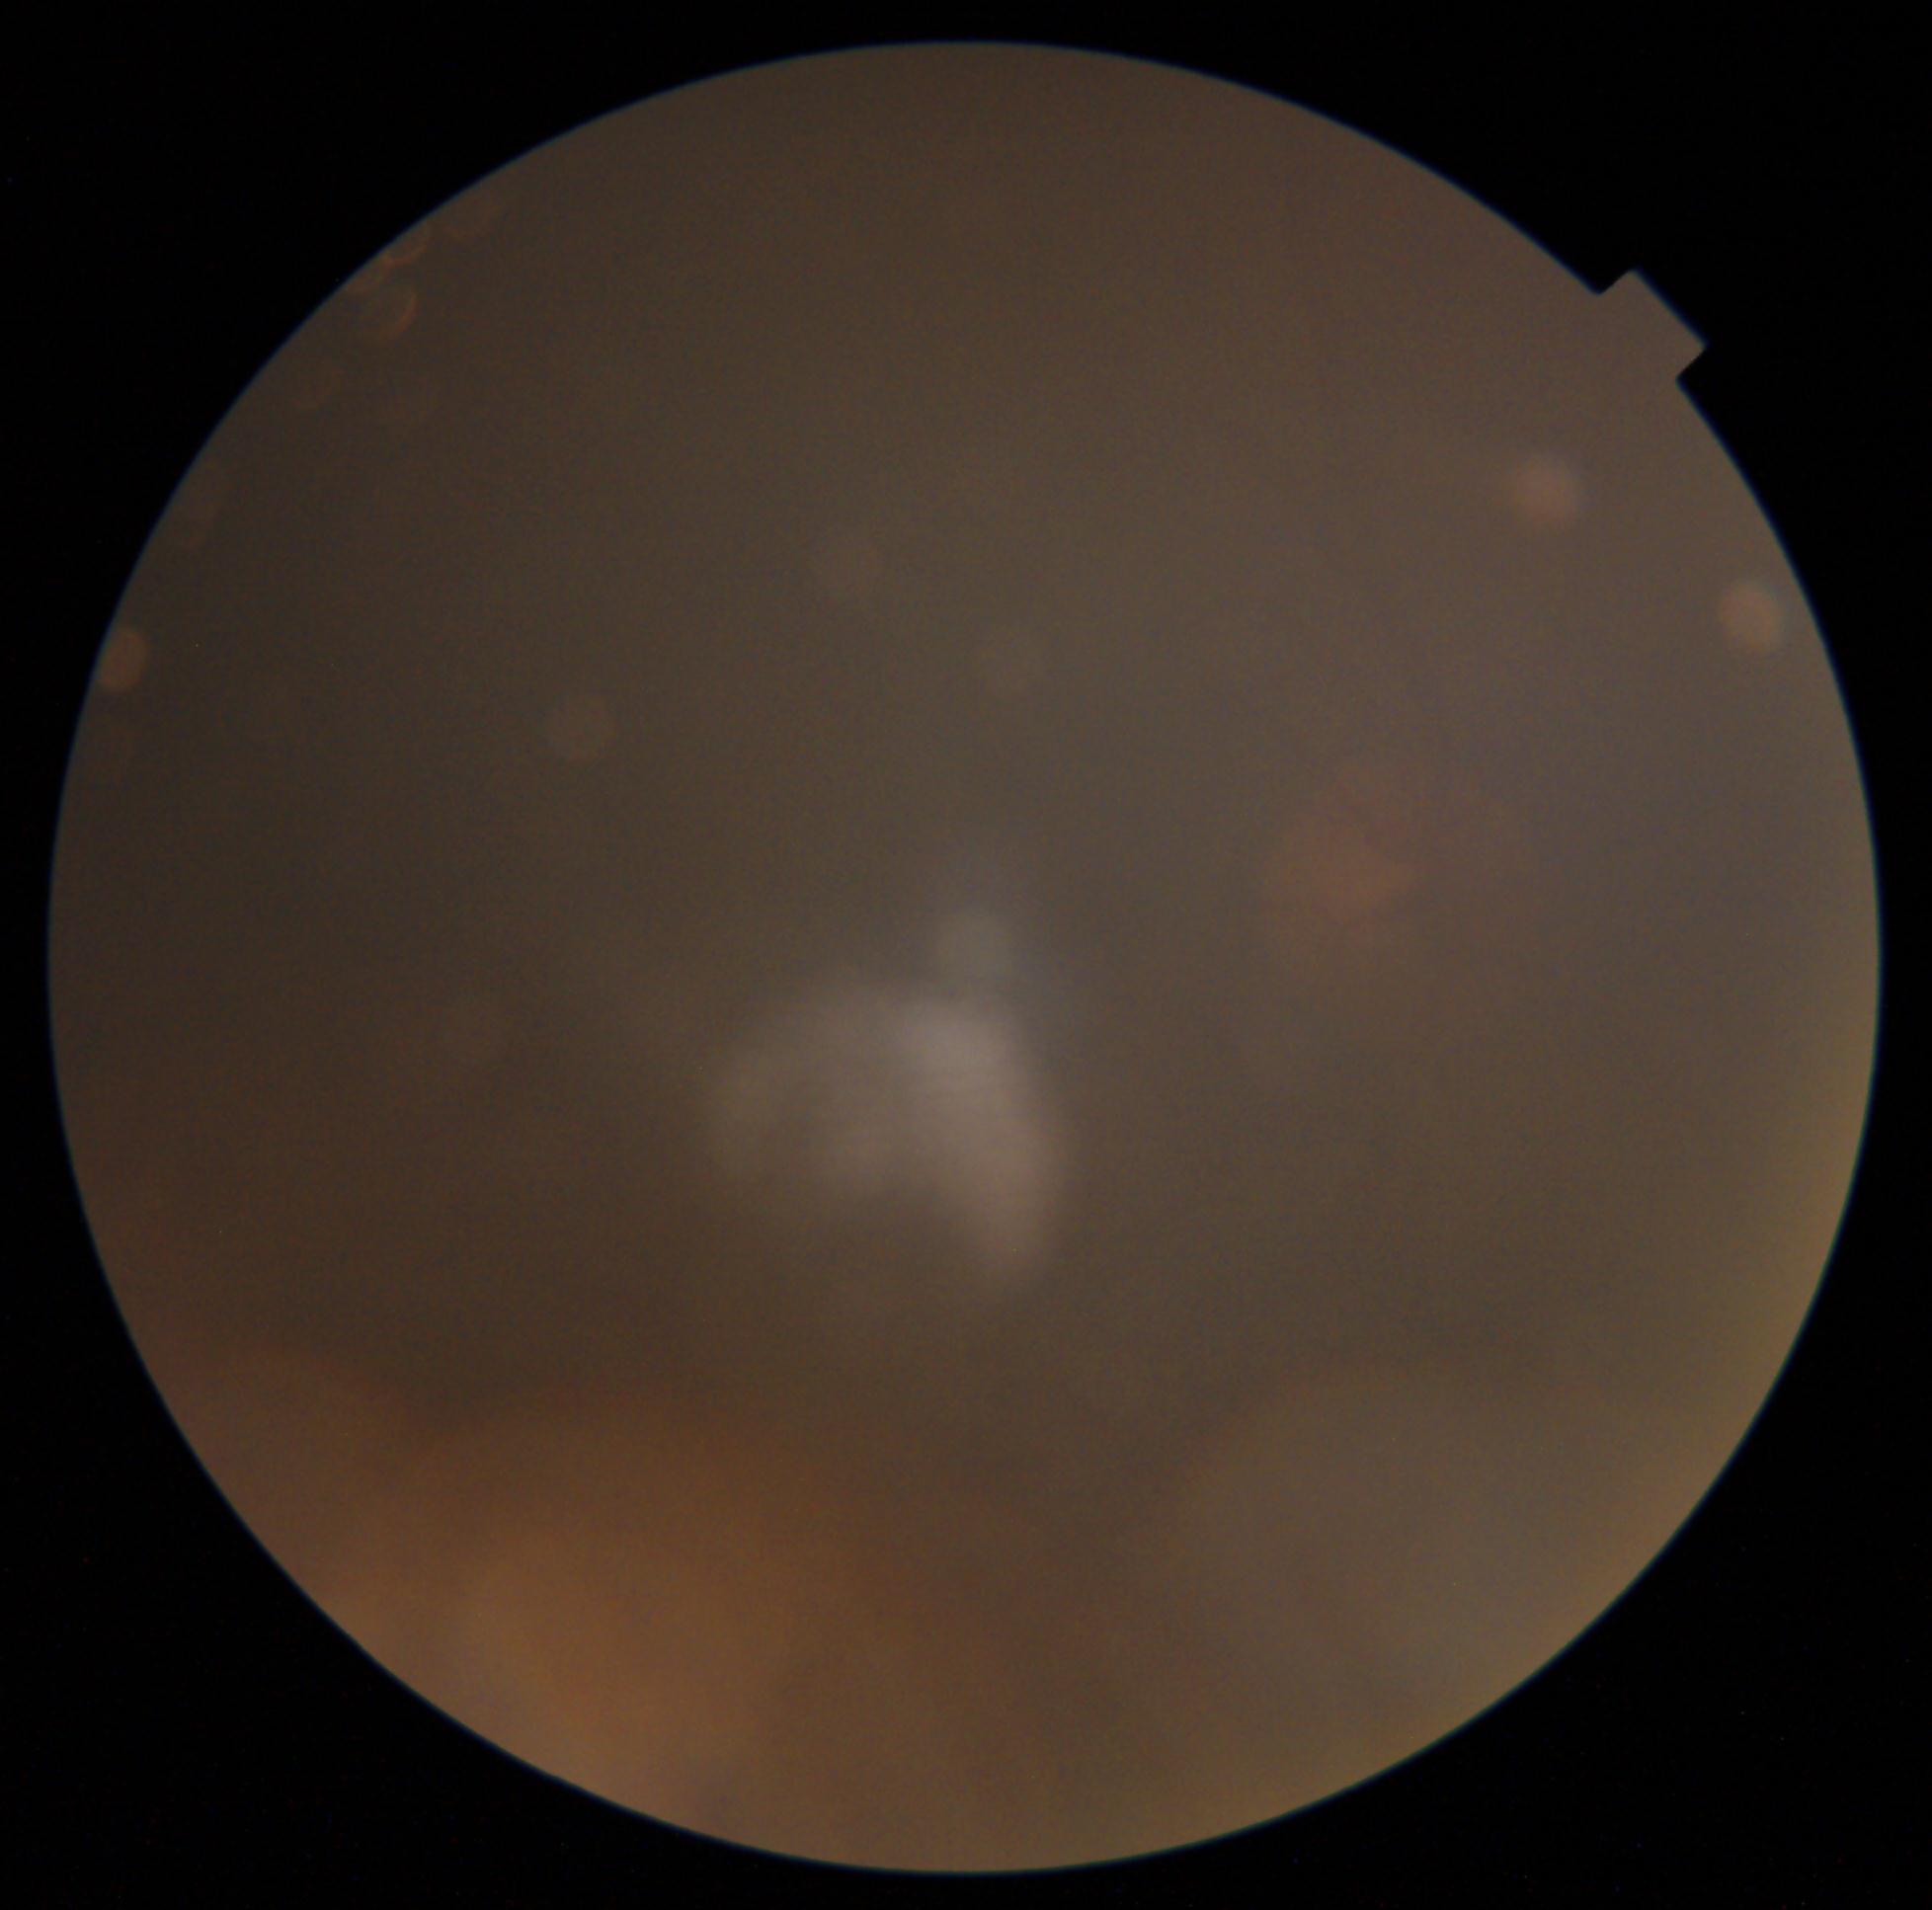

Quality too poor to assess for DR. Diabetic retinopathy severity is ungradable due to poor image quality.